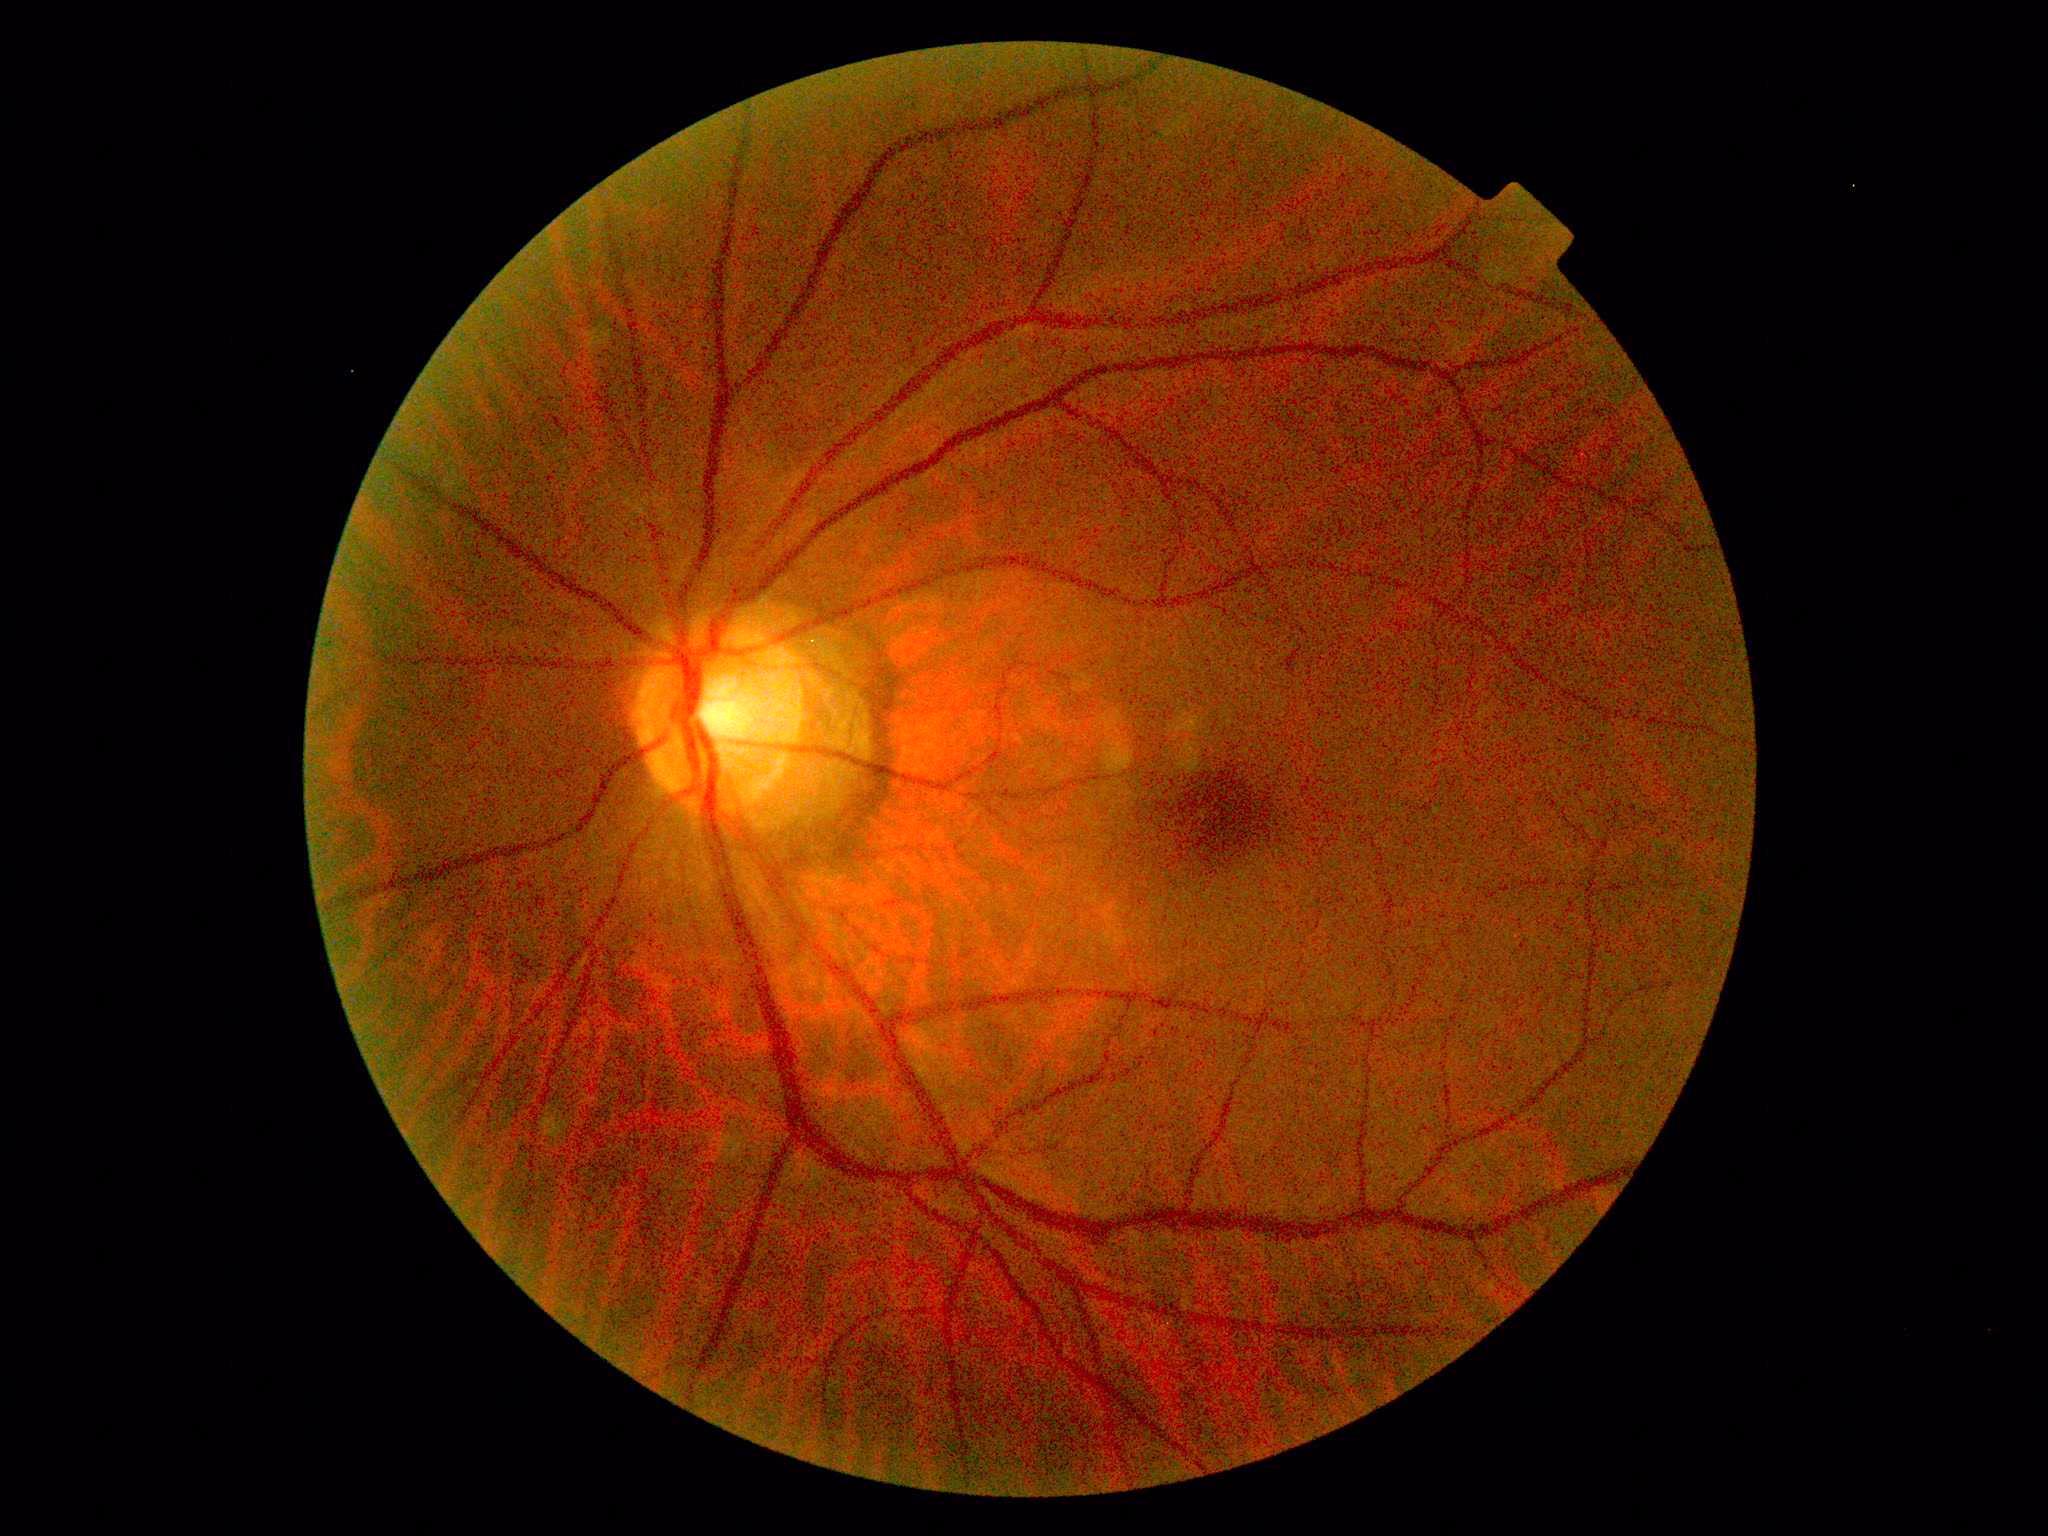
DR severity: grade 1 (mild NPDR).